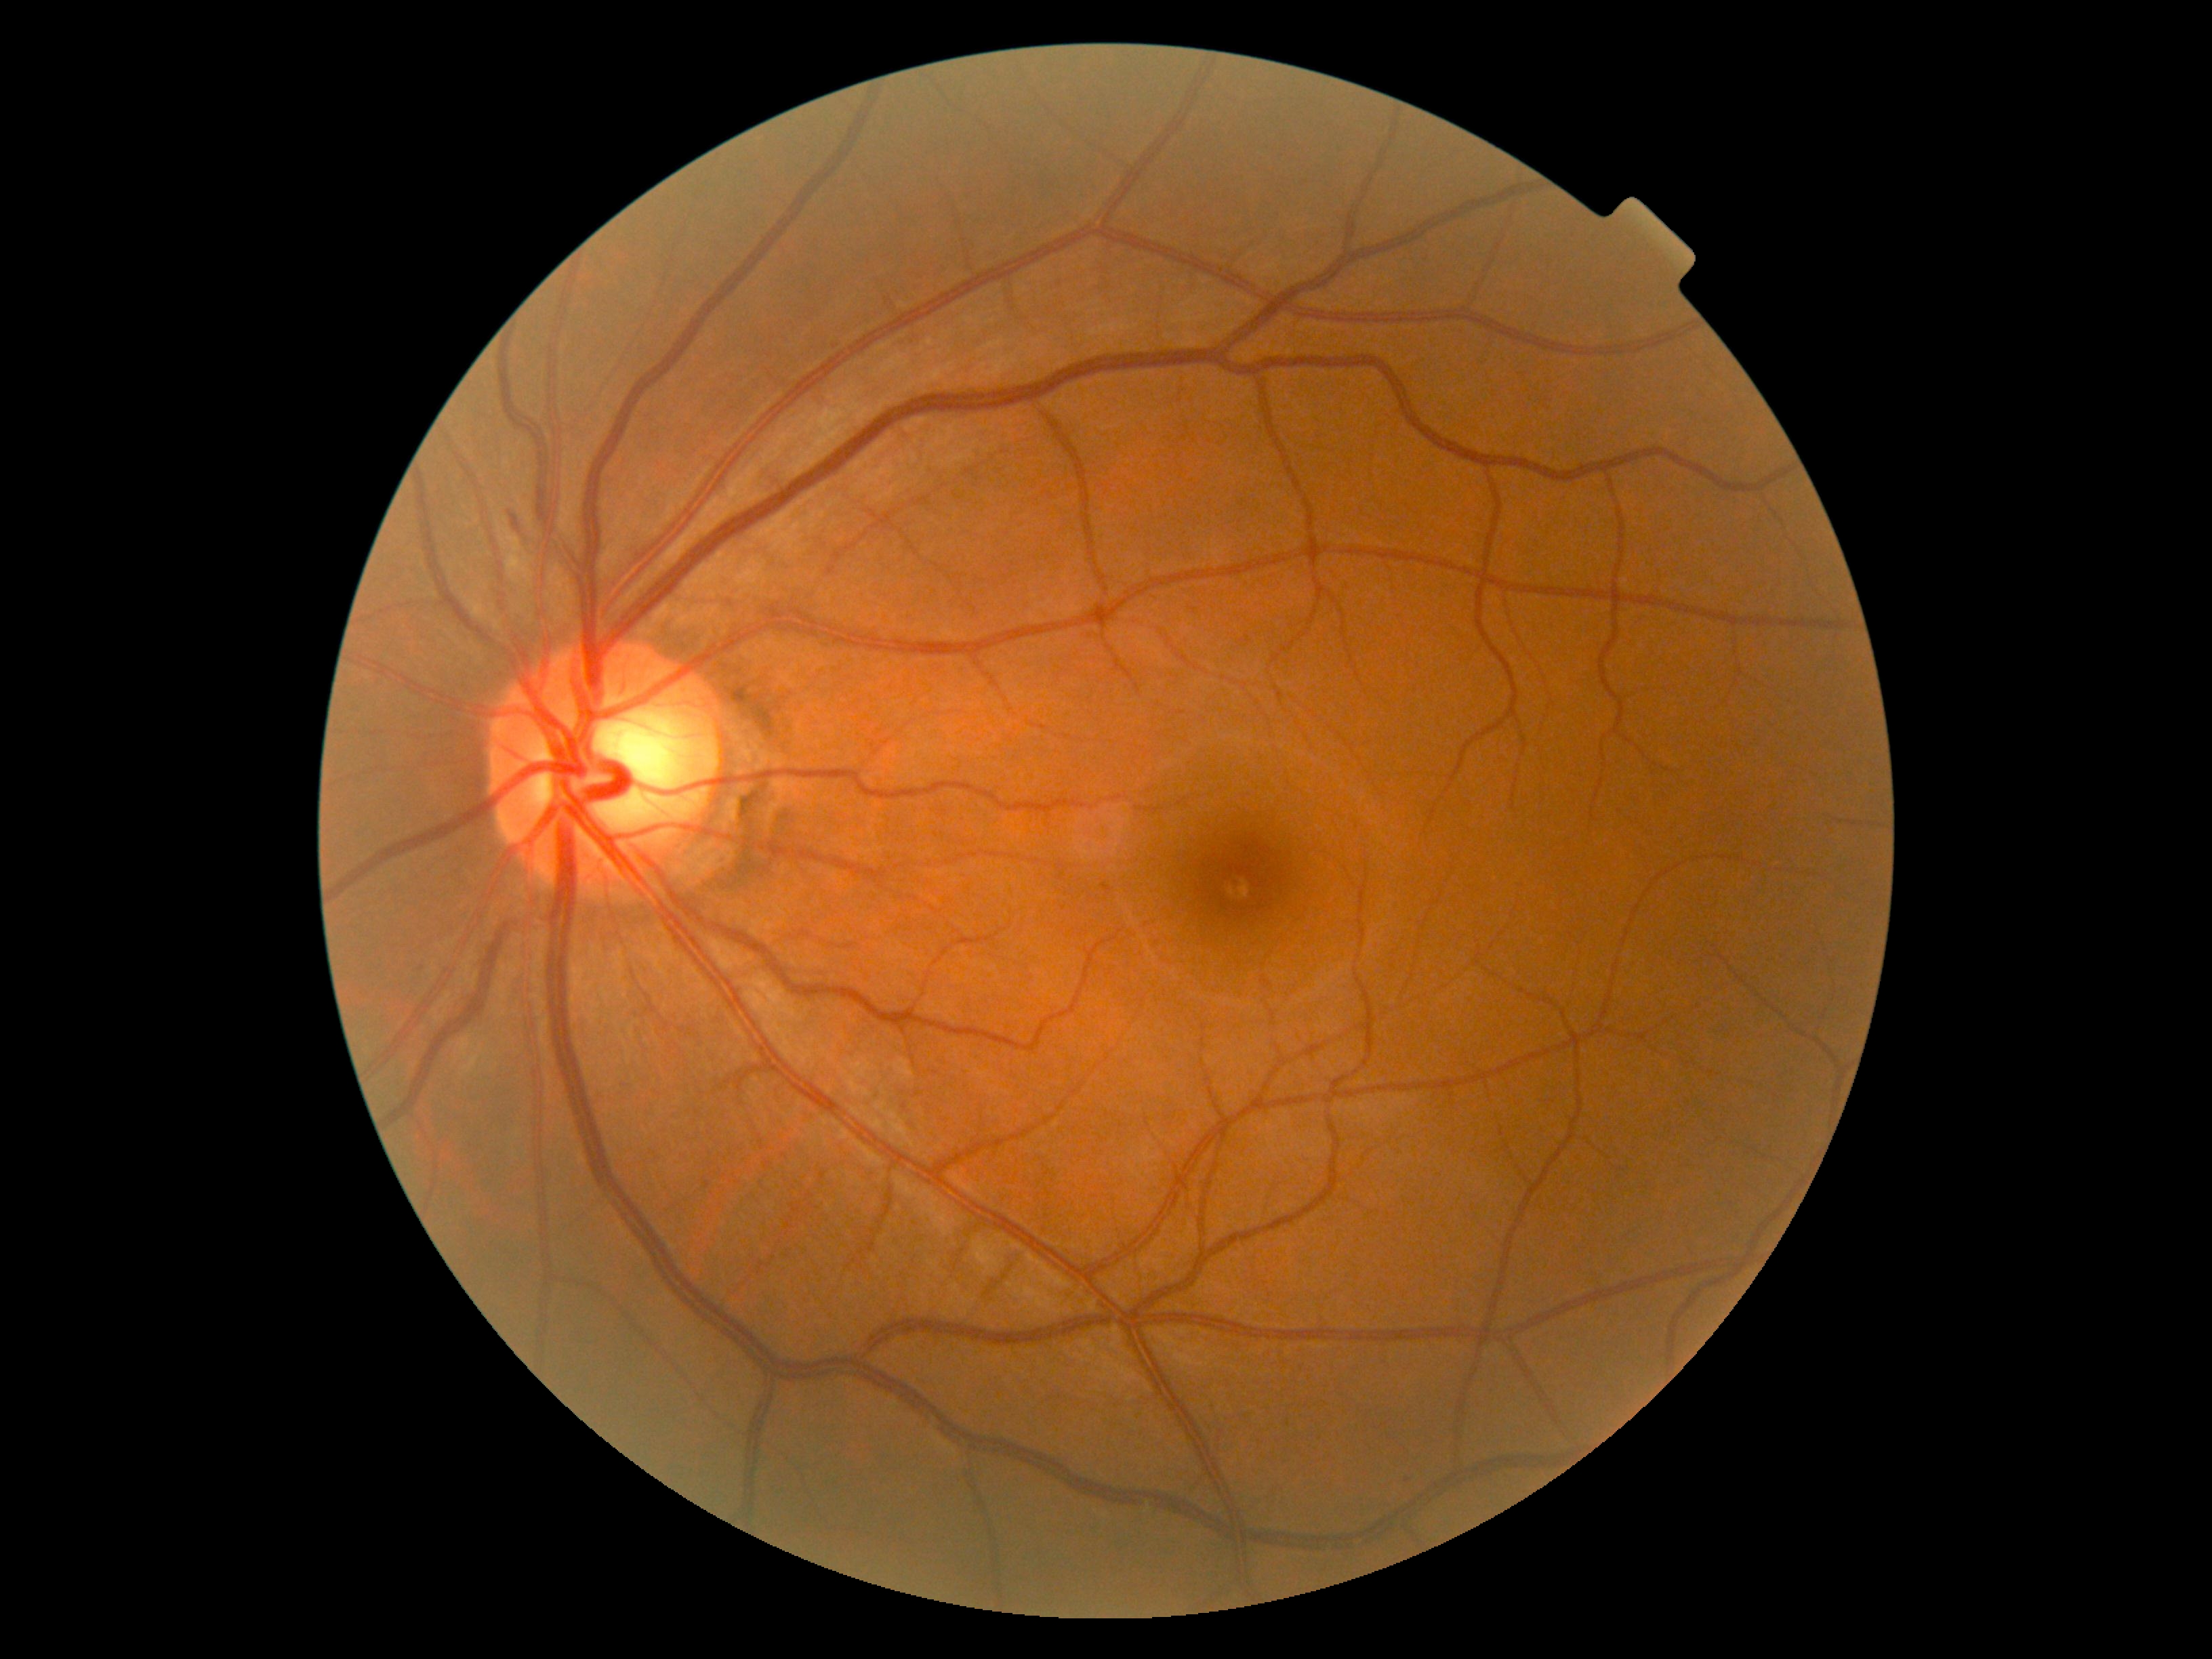

DR: grade 2 (moderate NPDR).